Infant wide-field retinal image · 1440x1080px — 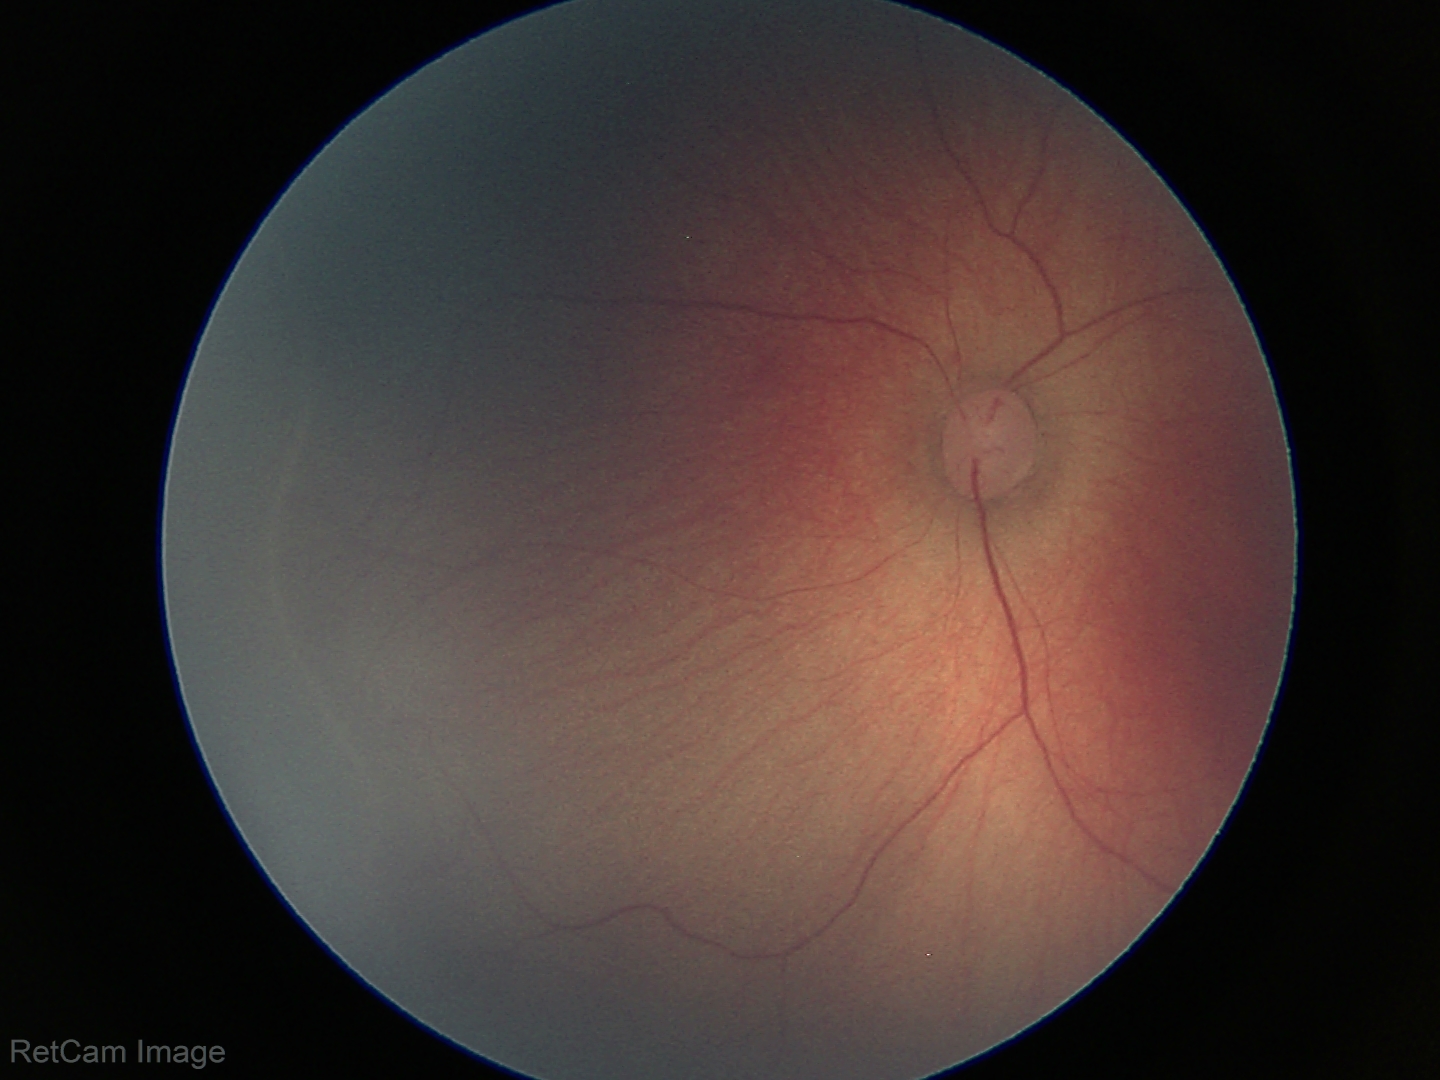
No plus disease. Examination diagnosed as ROP stage 1.